Nonmydriatic fundus photograph · posterior pole color fundus photograph · 45° FOV · NIDEK AFC-230.
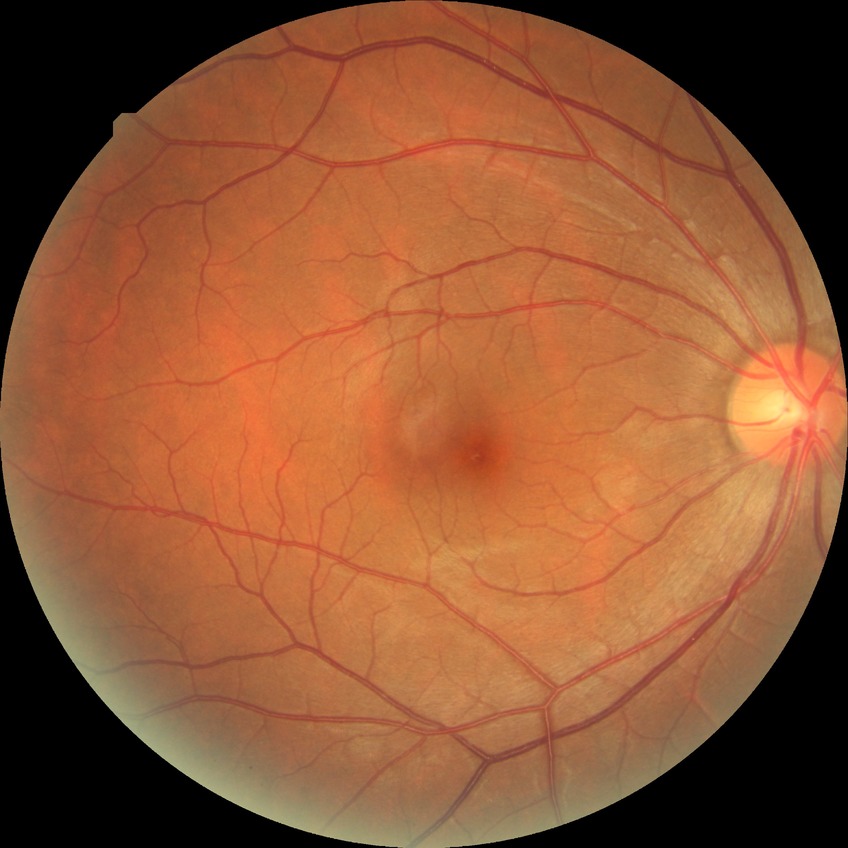

Davis grading: no diabetic retinopathy.